FOV: 45 degrees, 848 x 848 pixels
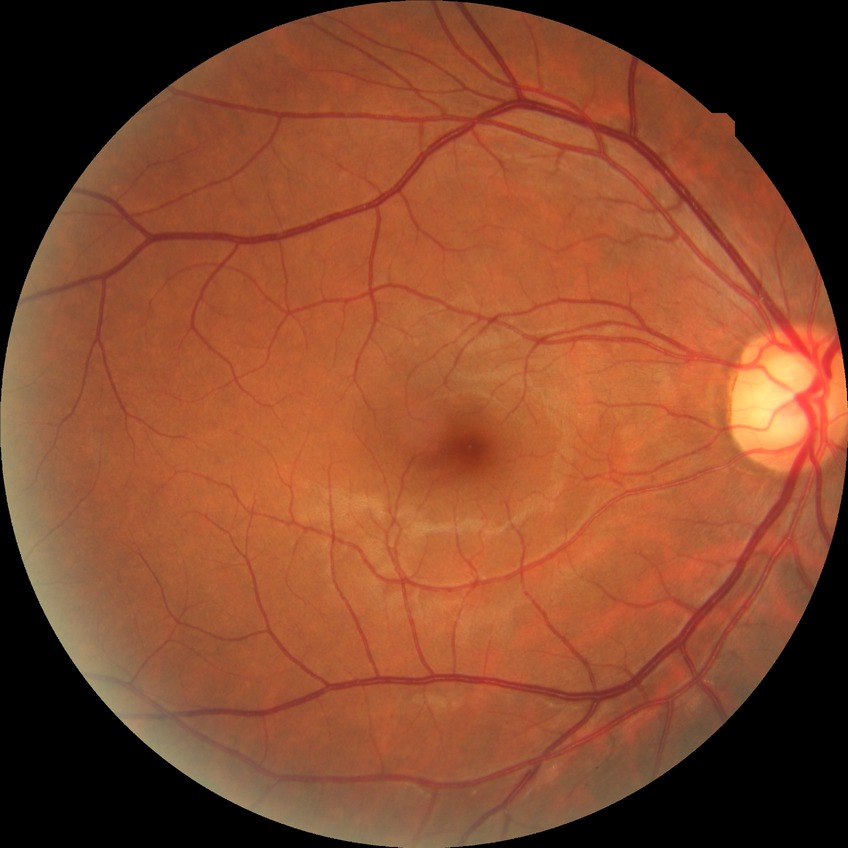 Modified Davis classification: no diabetic retinopathy.